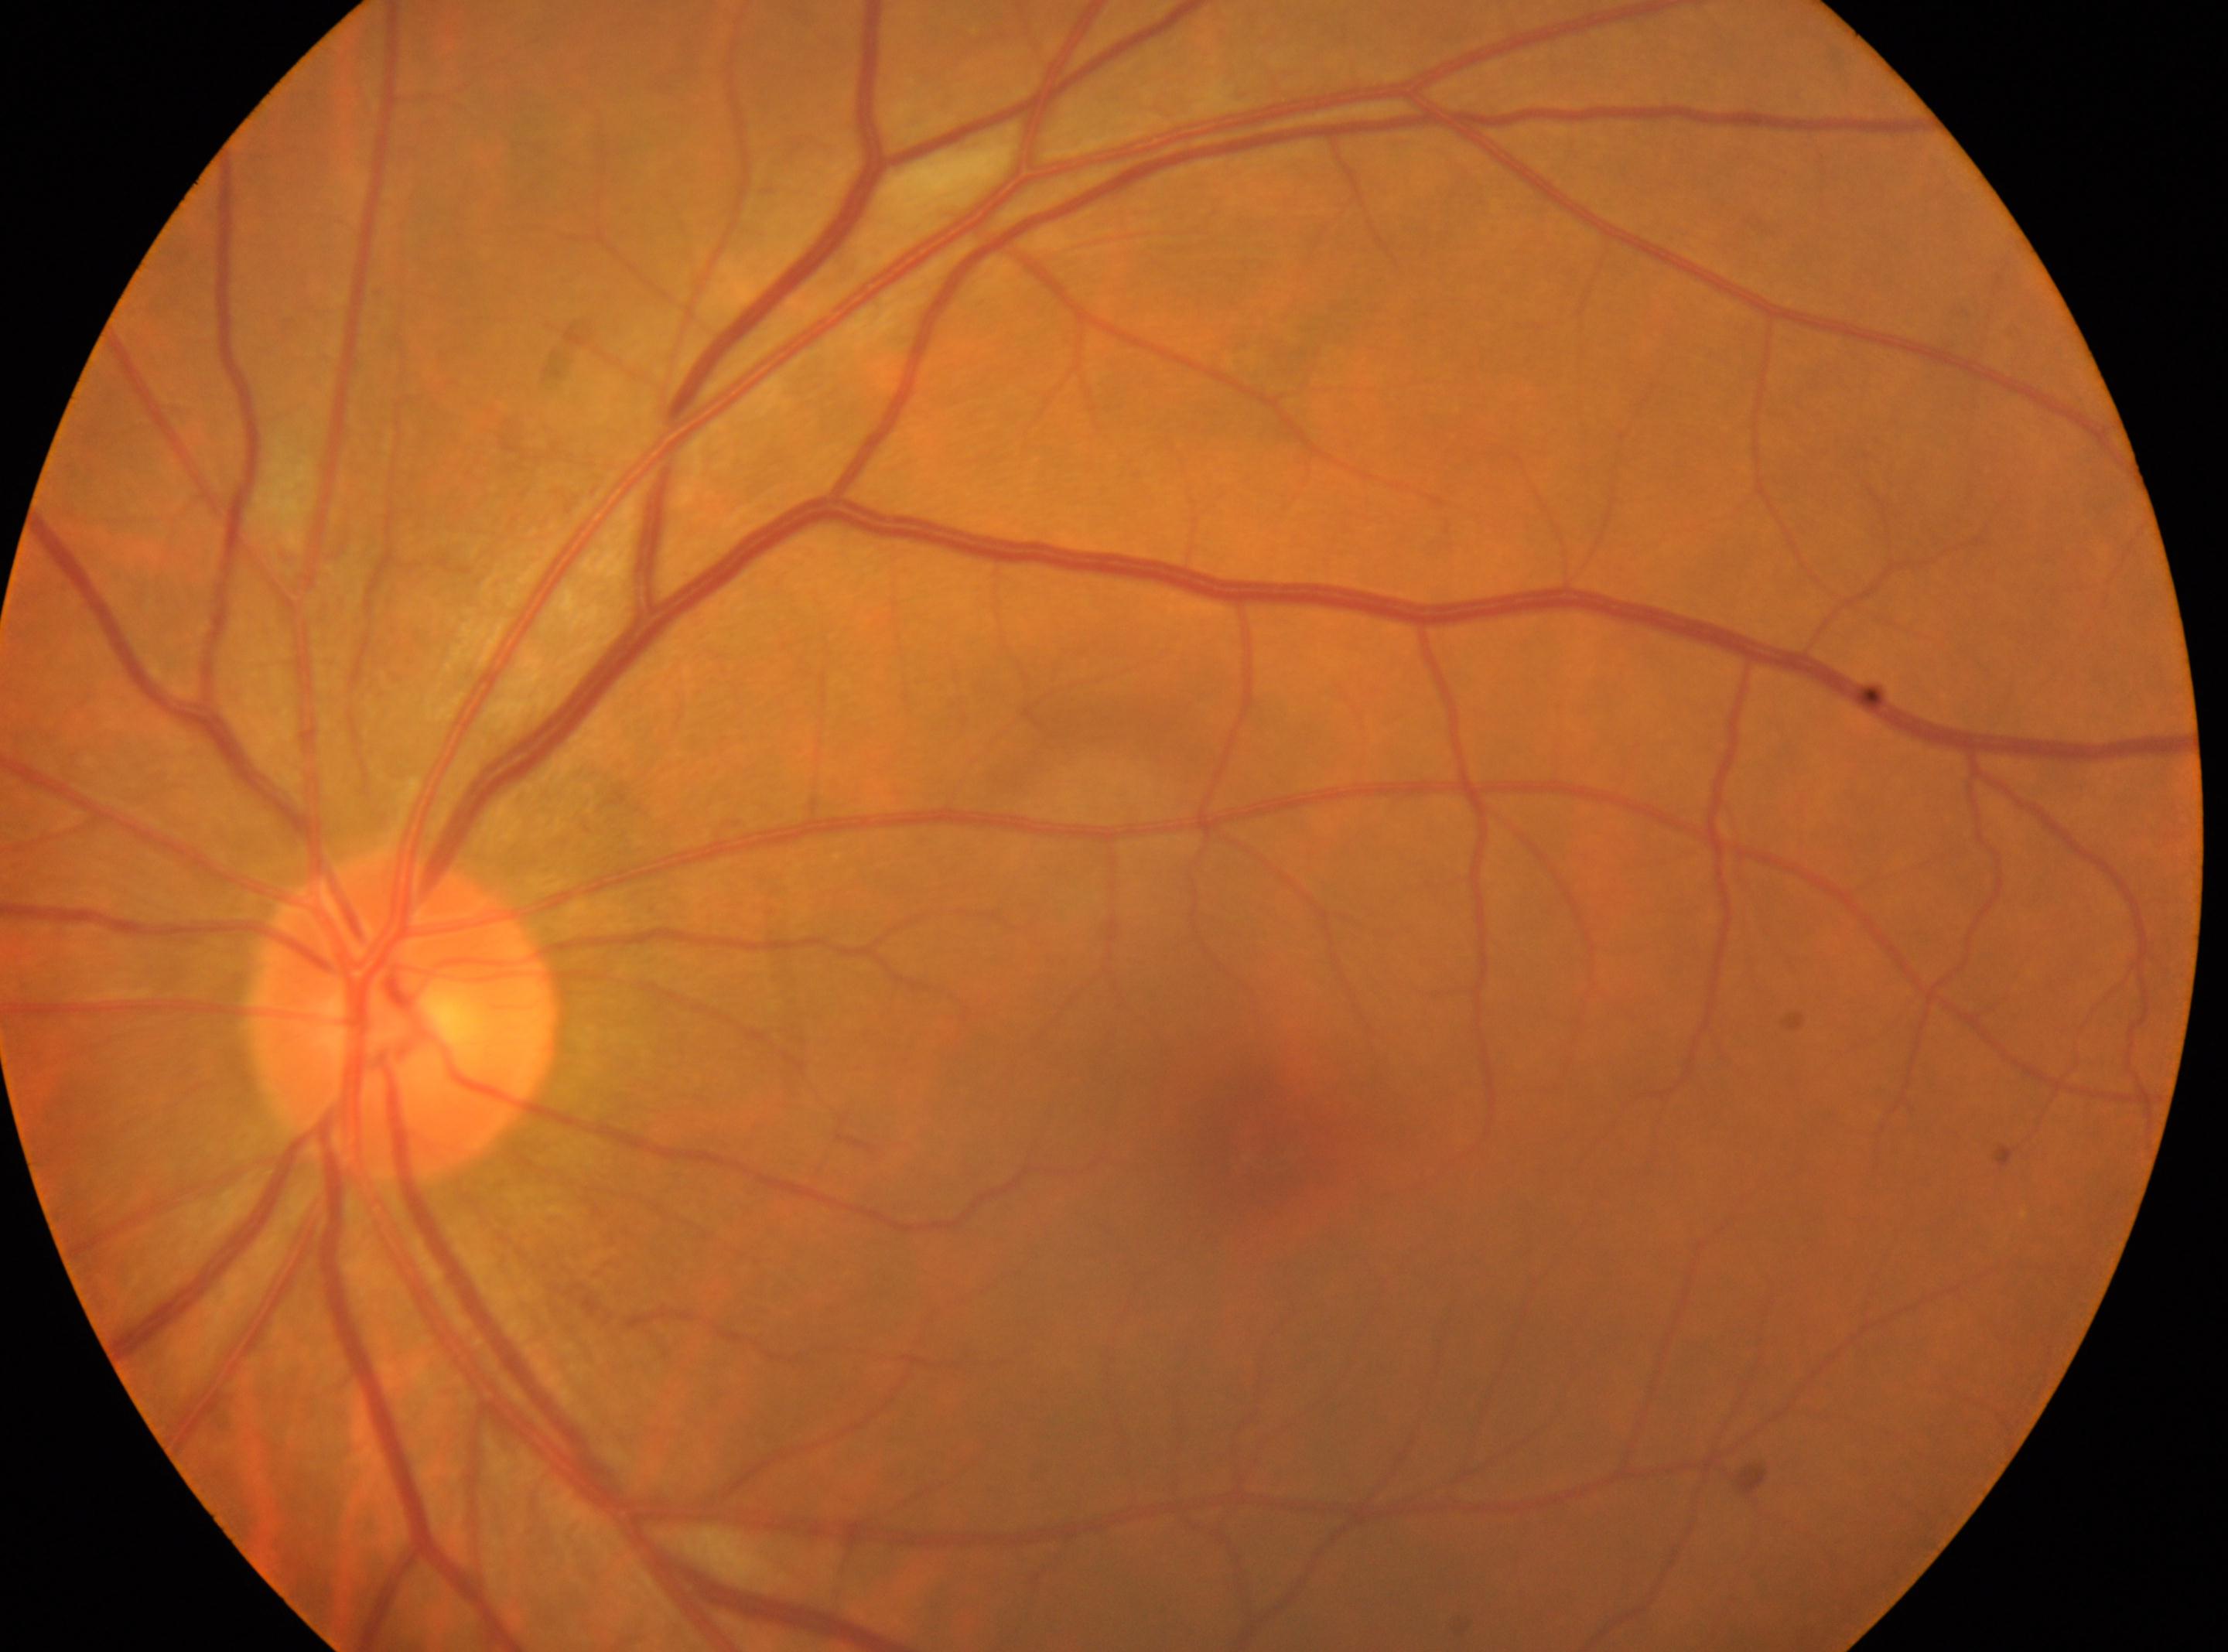

Imaged eye: oculus sinister. DR is 0. No diabetic retinopathy identified. The foveal center is at (1256, 1135). Optic disc located at (405, 1016).